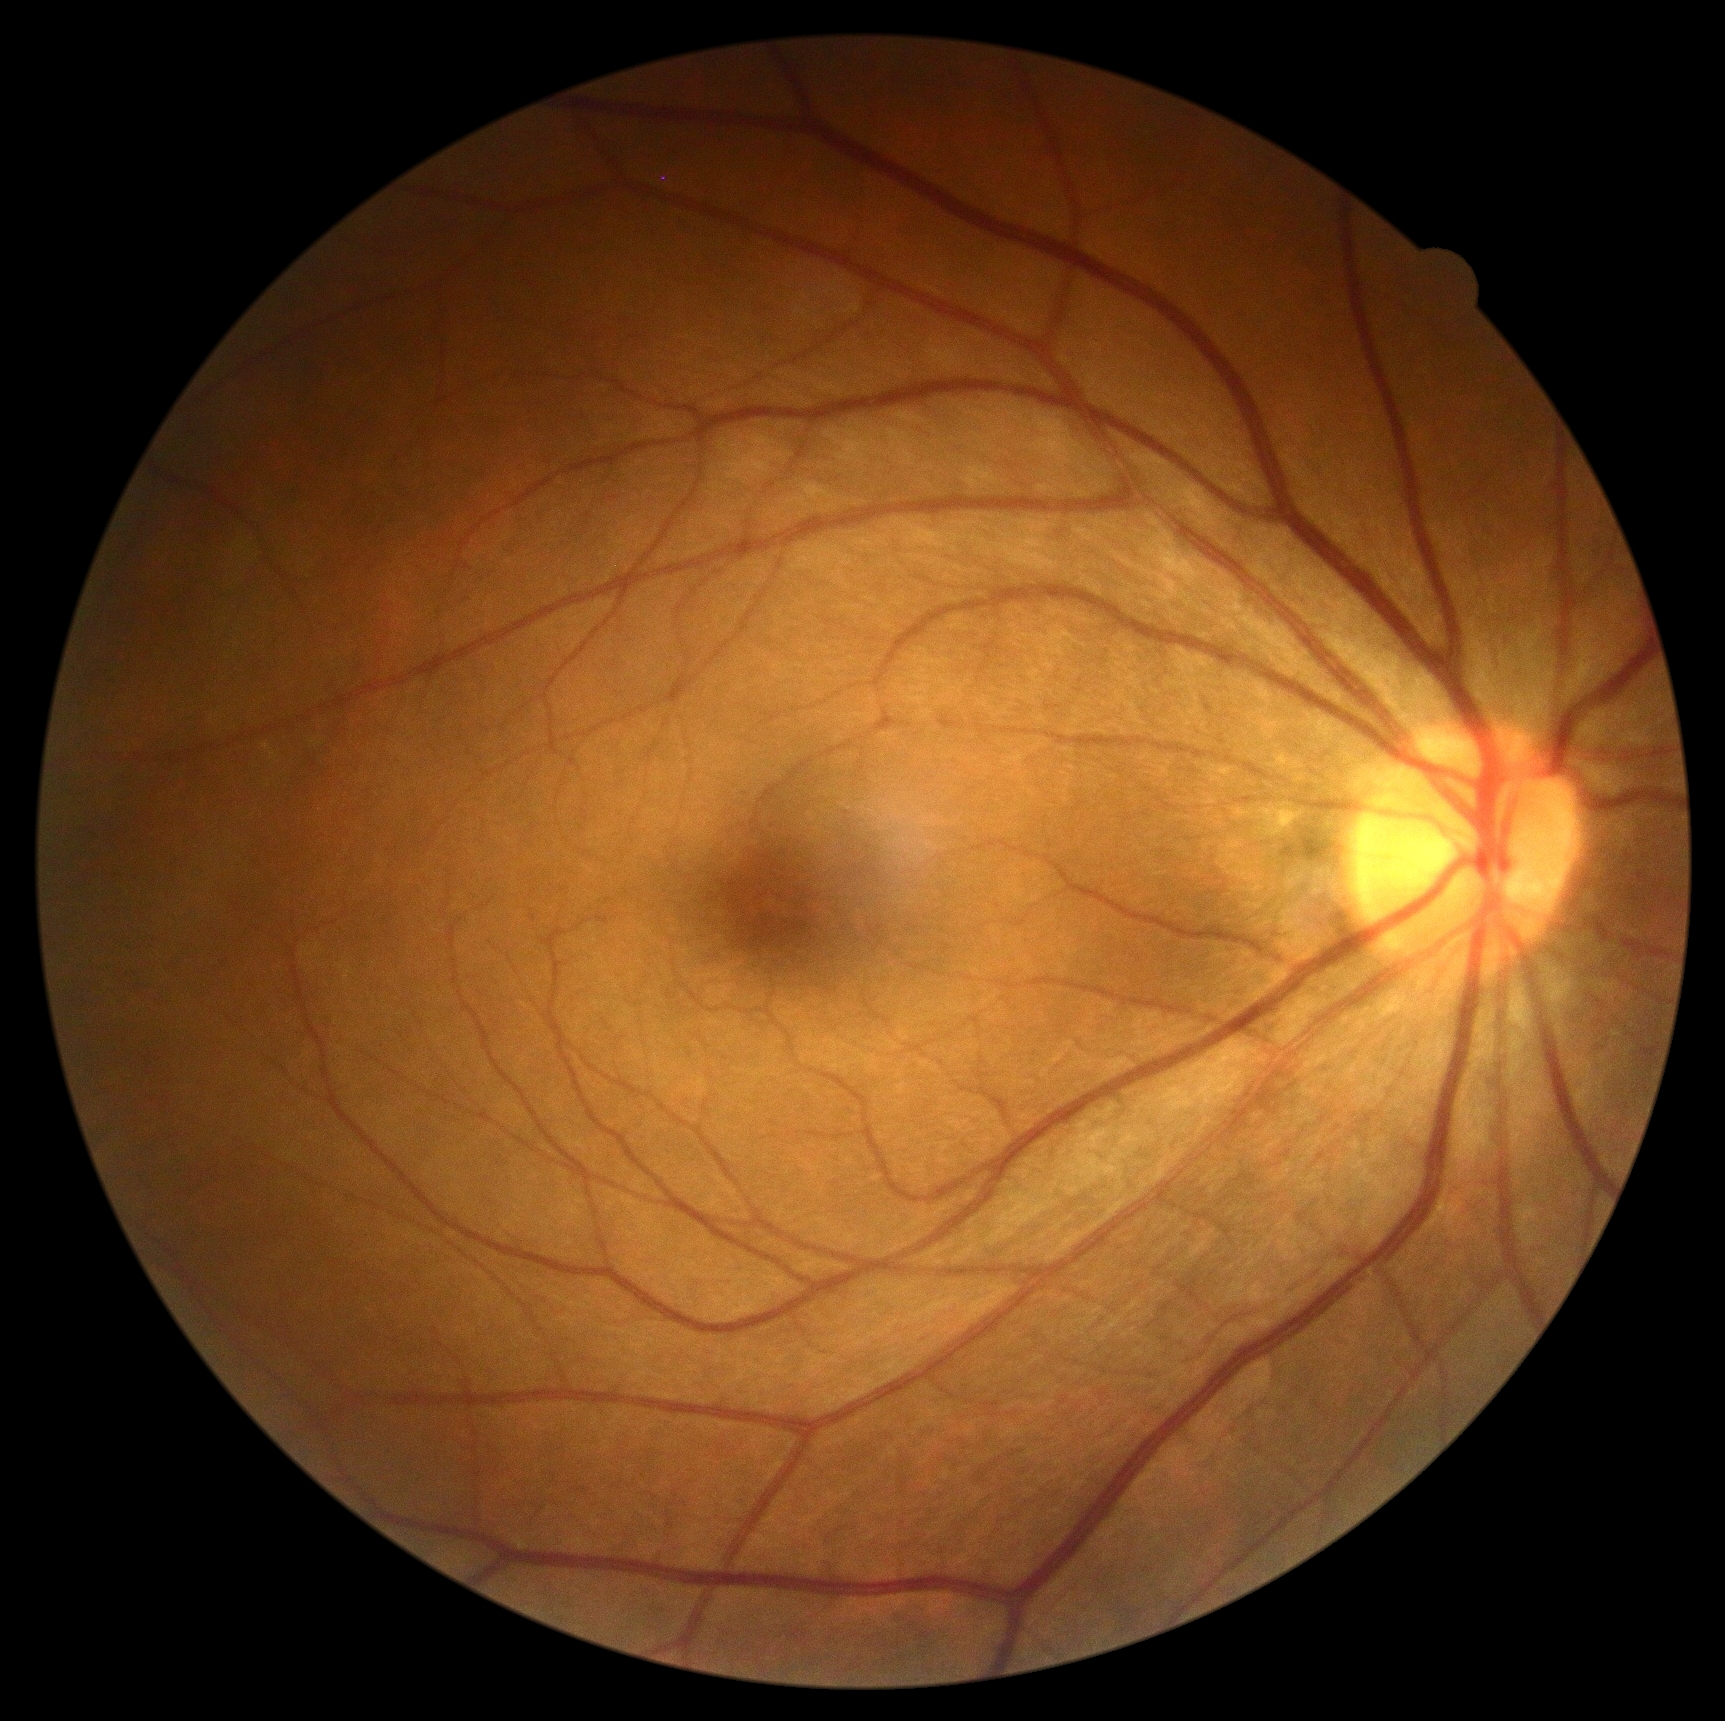

retinopathy grade = no apparent retinopathy (0)
DR impression = no DR findings